NIDEK AFC-230, diabetic retinopathy graded by the modified Davis classification, 848 x 848 pixels, posterior pole color fundus photograph: 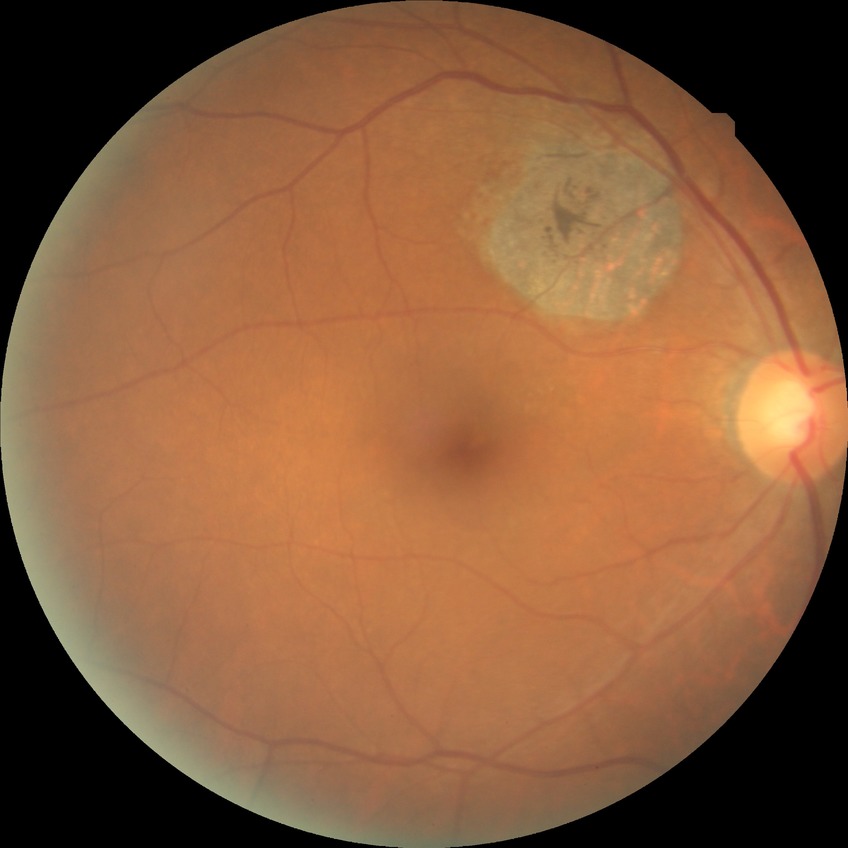

Diabetic retinopathy (DR) is NDR (no diabetic retinopathy).